1240x1240; wide-field contact fundus photograph of an infant.
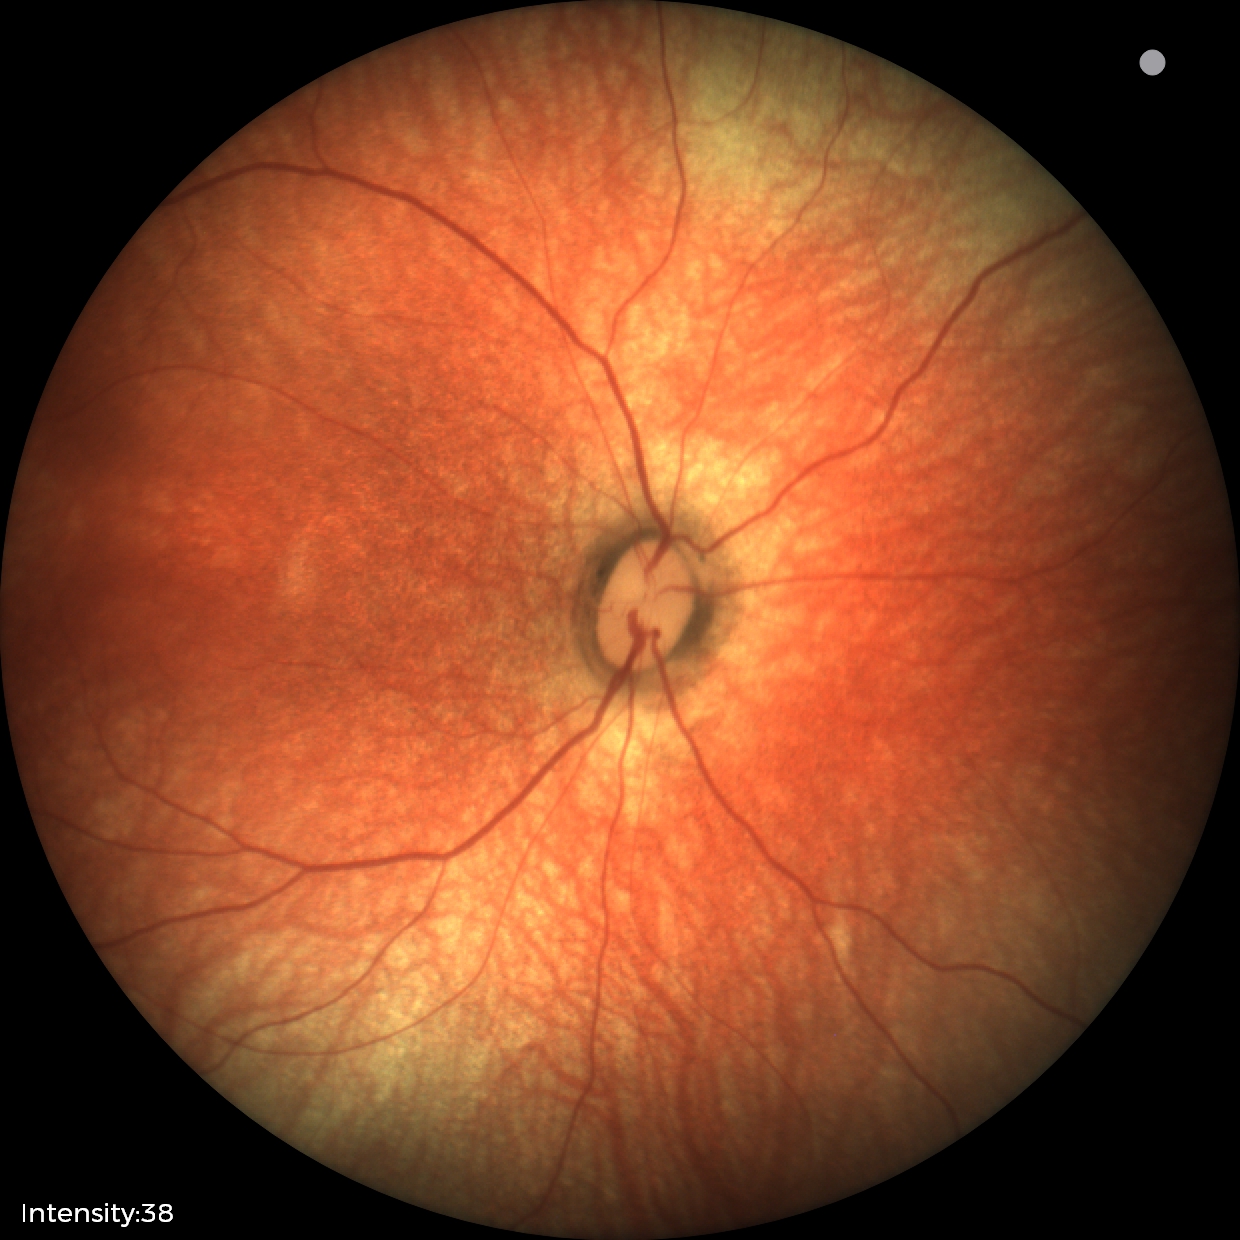

Screening examination with no abnormal retinal findings.